DR severity per modified Davis staging:
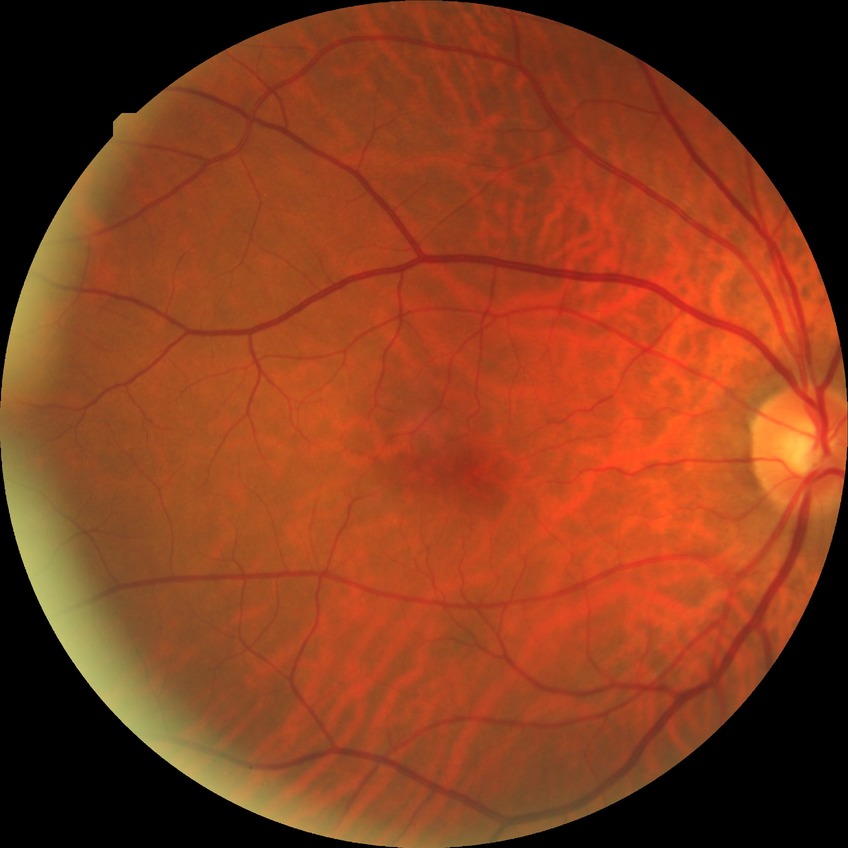

Findings:
– DR stage — NDR